Optic nerve head crop · non-mydriatic acquisition · image size 240x240:
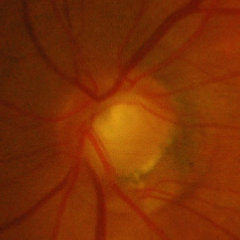
Glaucomatous optic neuropathy is present. Findings consistent with advanced-stage glaucoma.